2352x1568px: 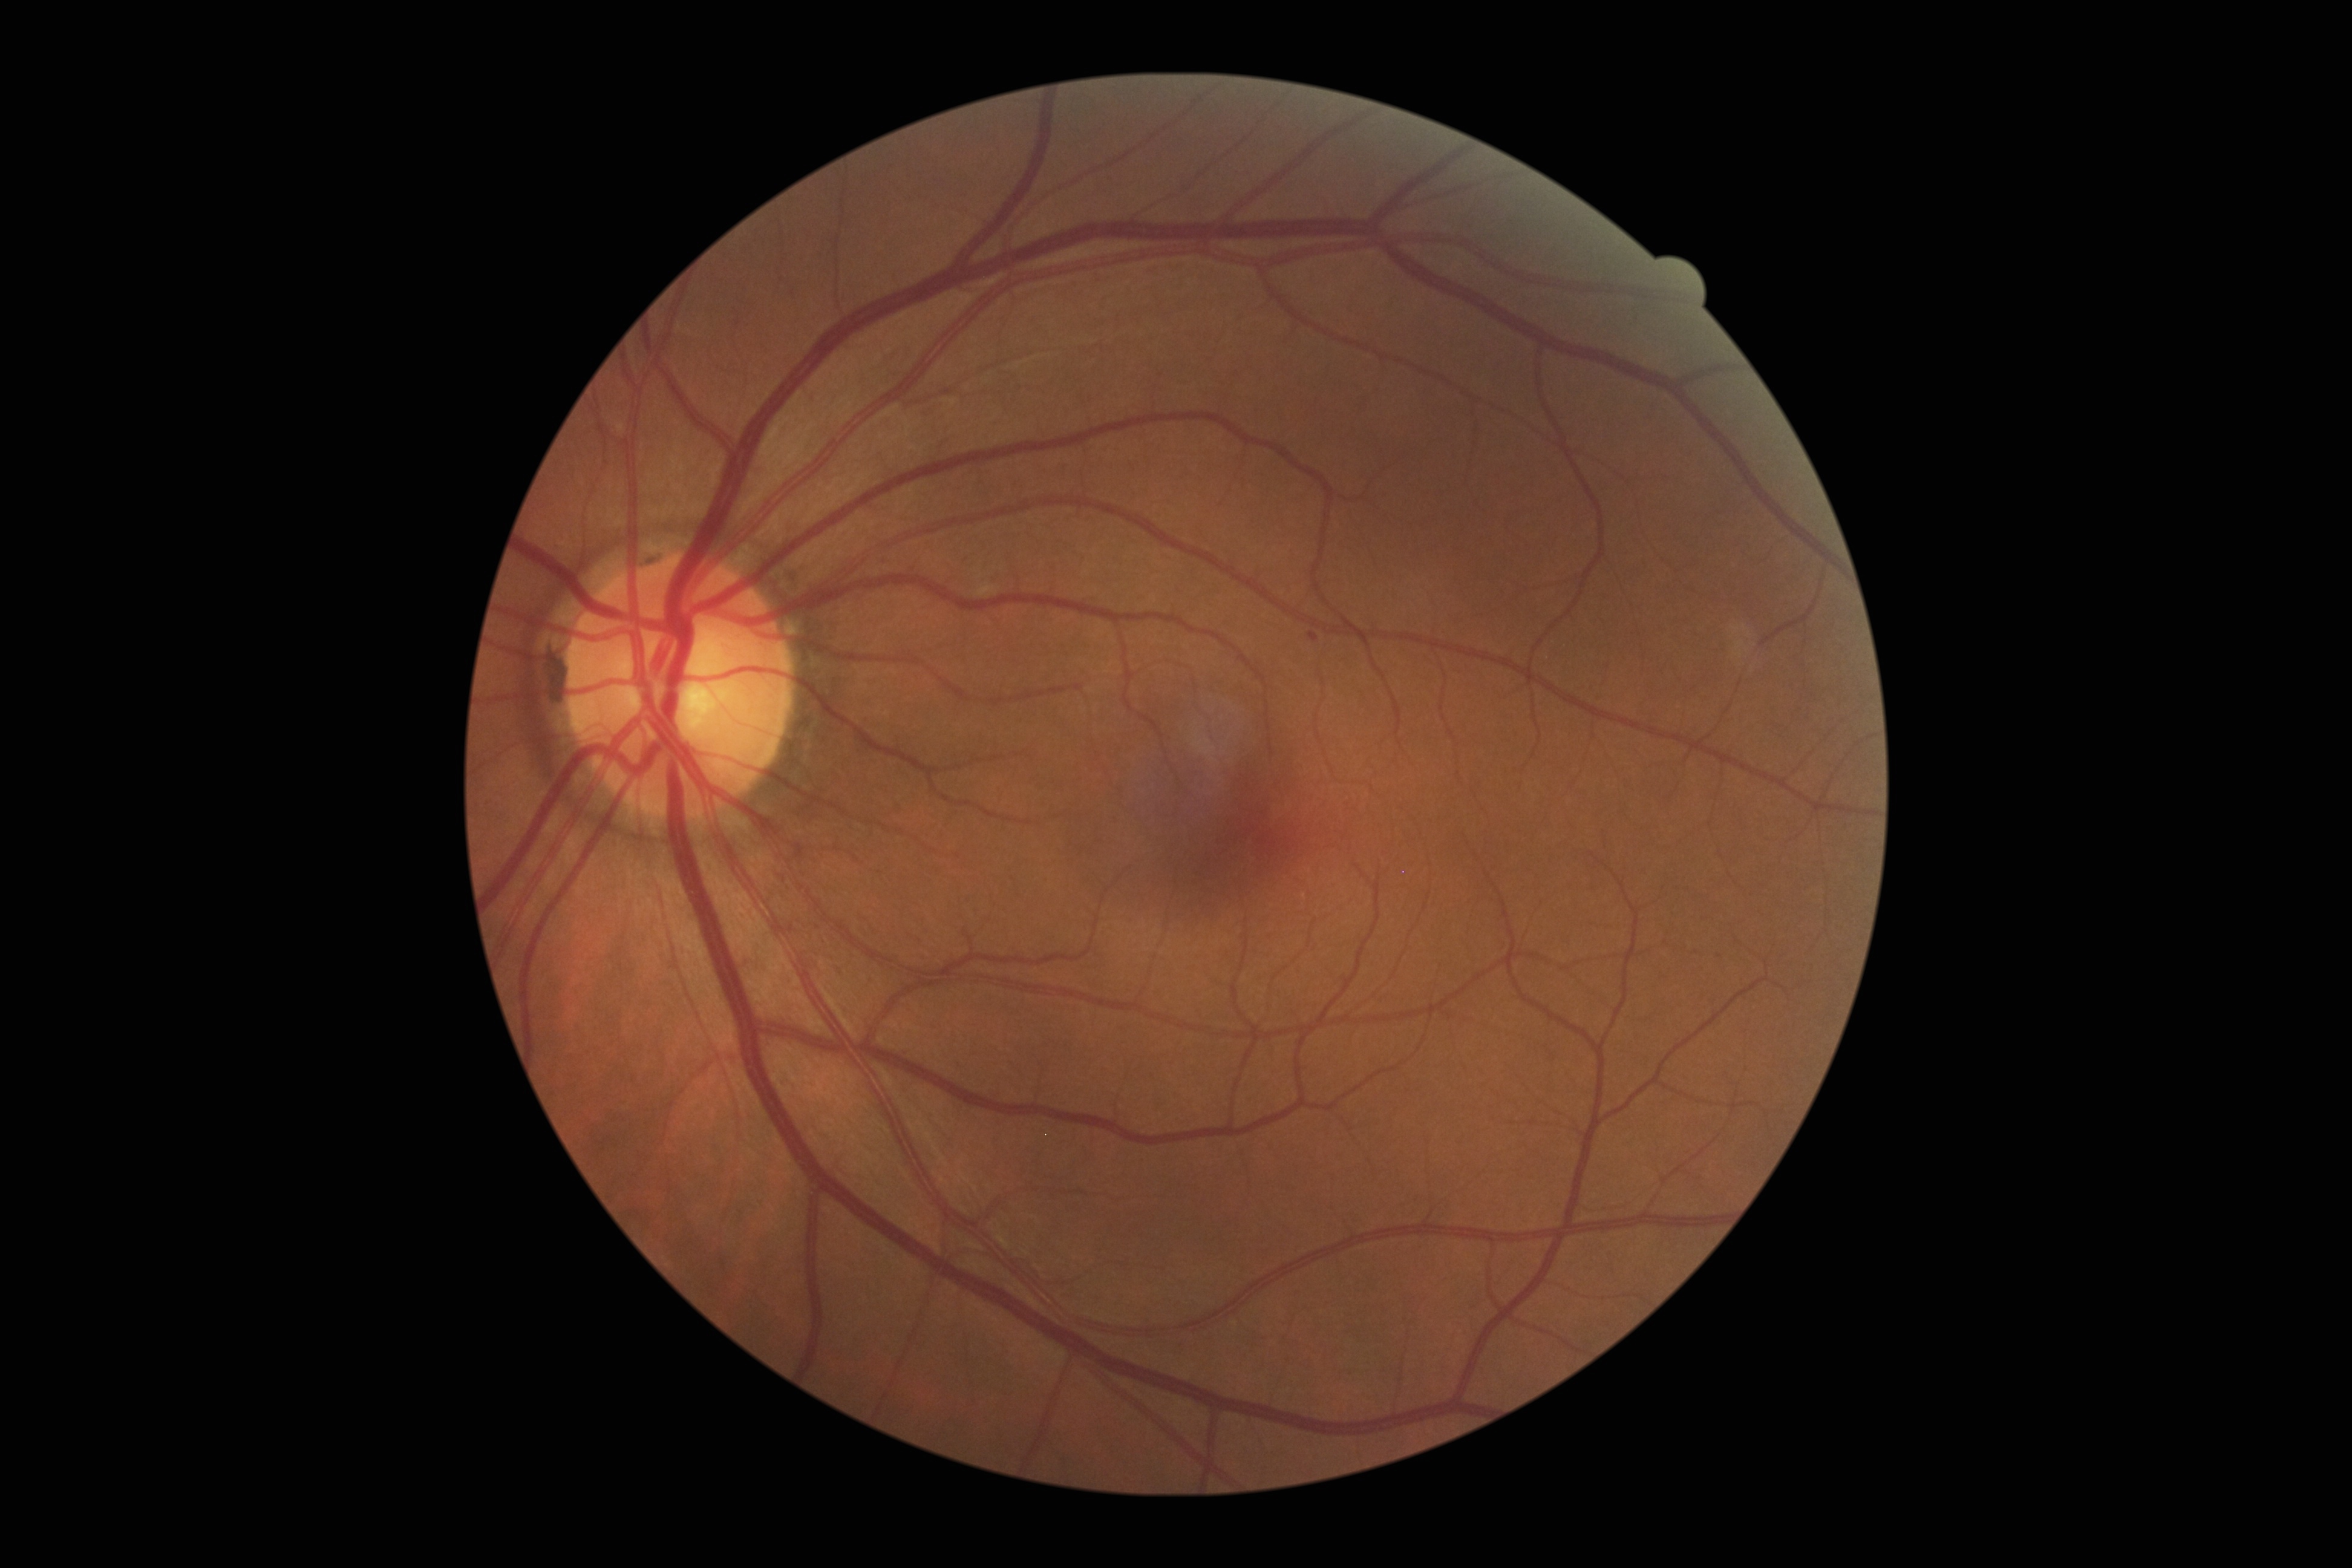
Diabetic retinopathy (DR): grade 1 — presence of microaneurysms only
hemorrhages (HEs): absent
microaneurysms (MAs): {"left": 1308, "top": 631, "right": 1319, "bottom": 643}
hard exudates (EXs): absent
soft exudates (SEs): absent